Fundus photo; 2352 by 1568 pixels; 45° field of view:
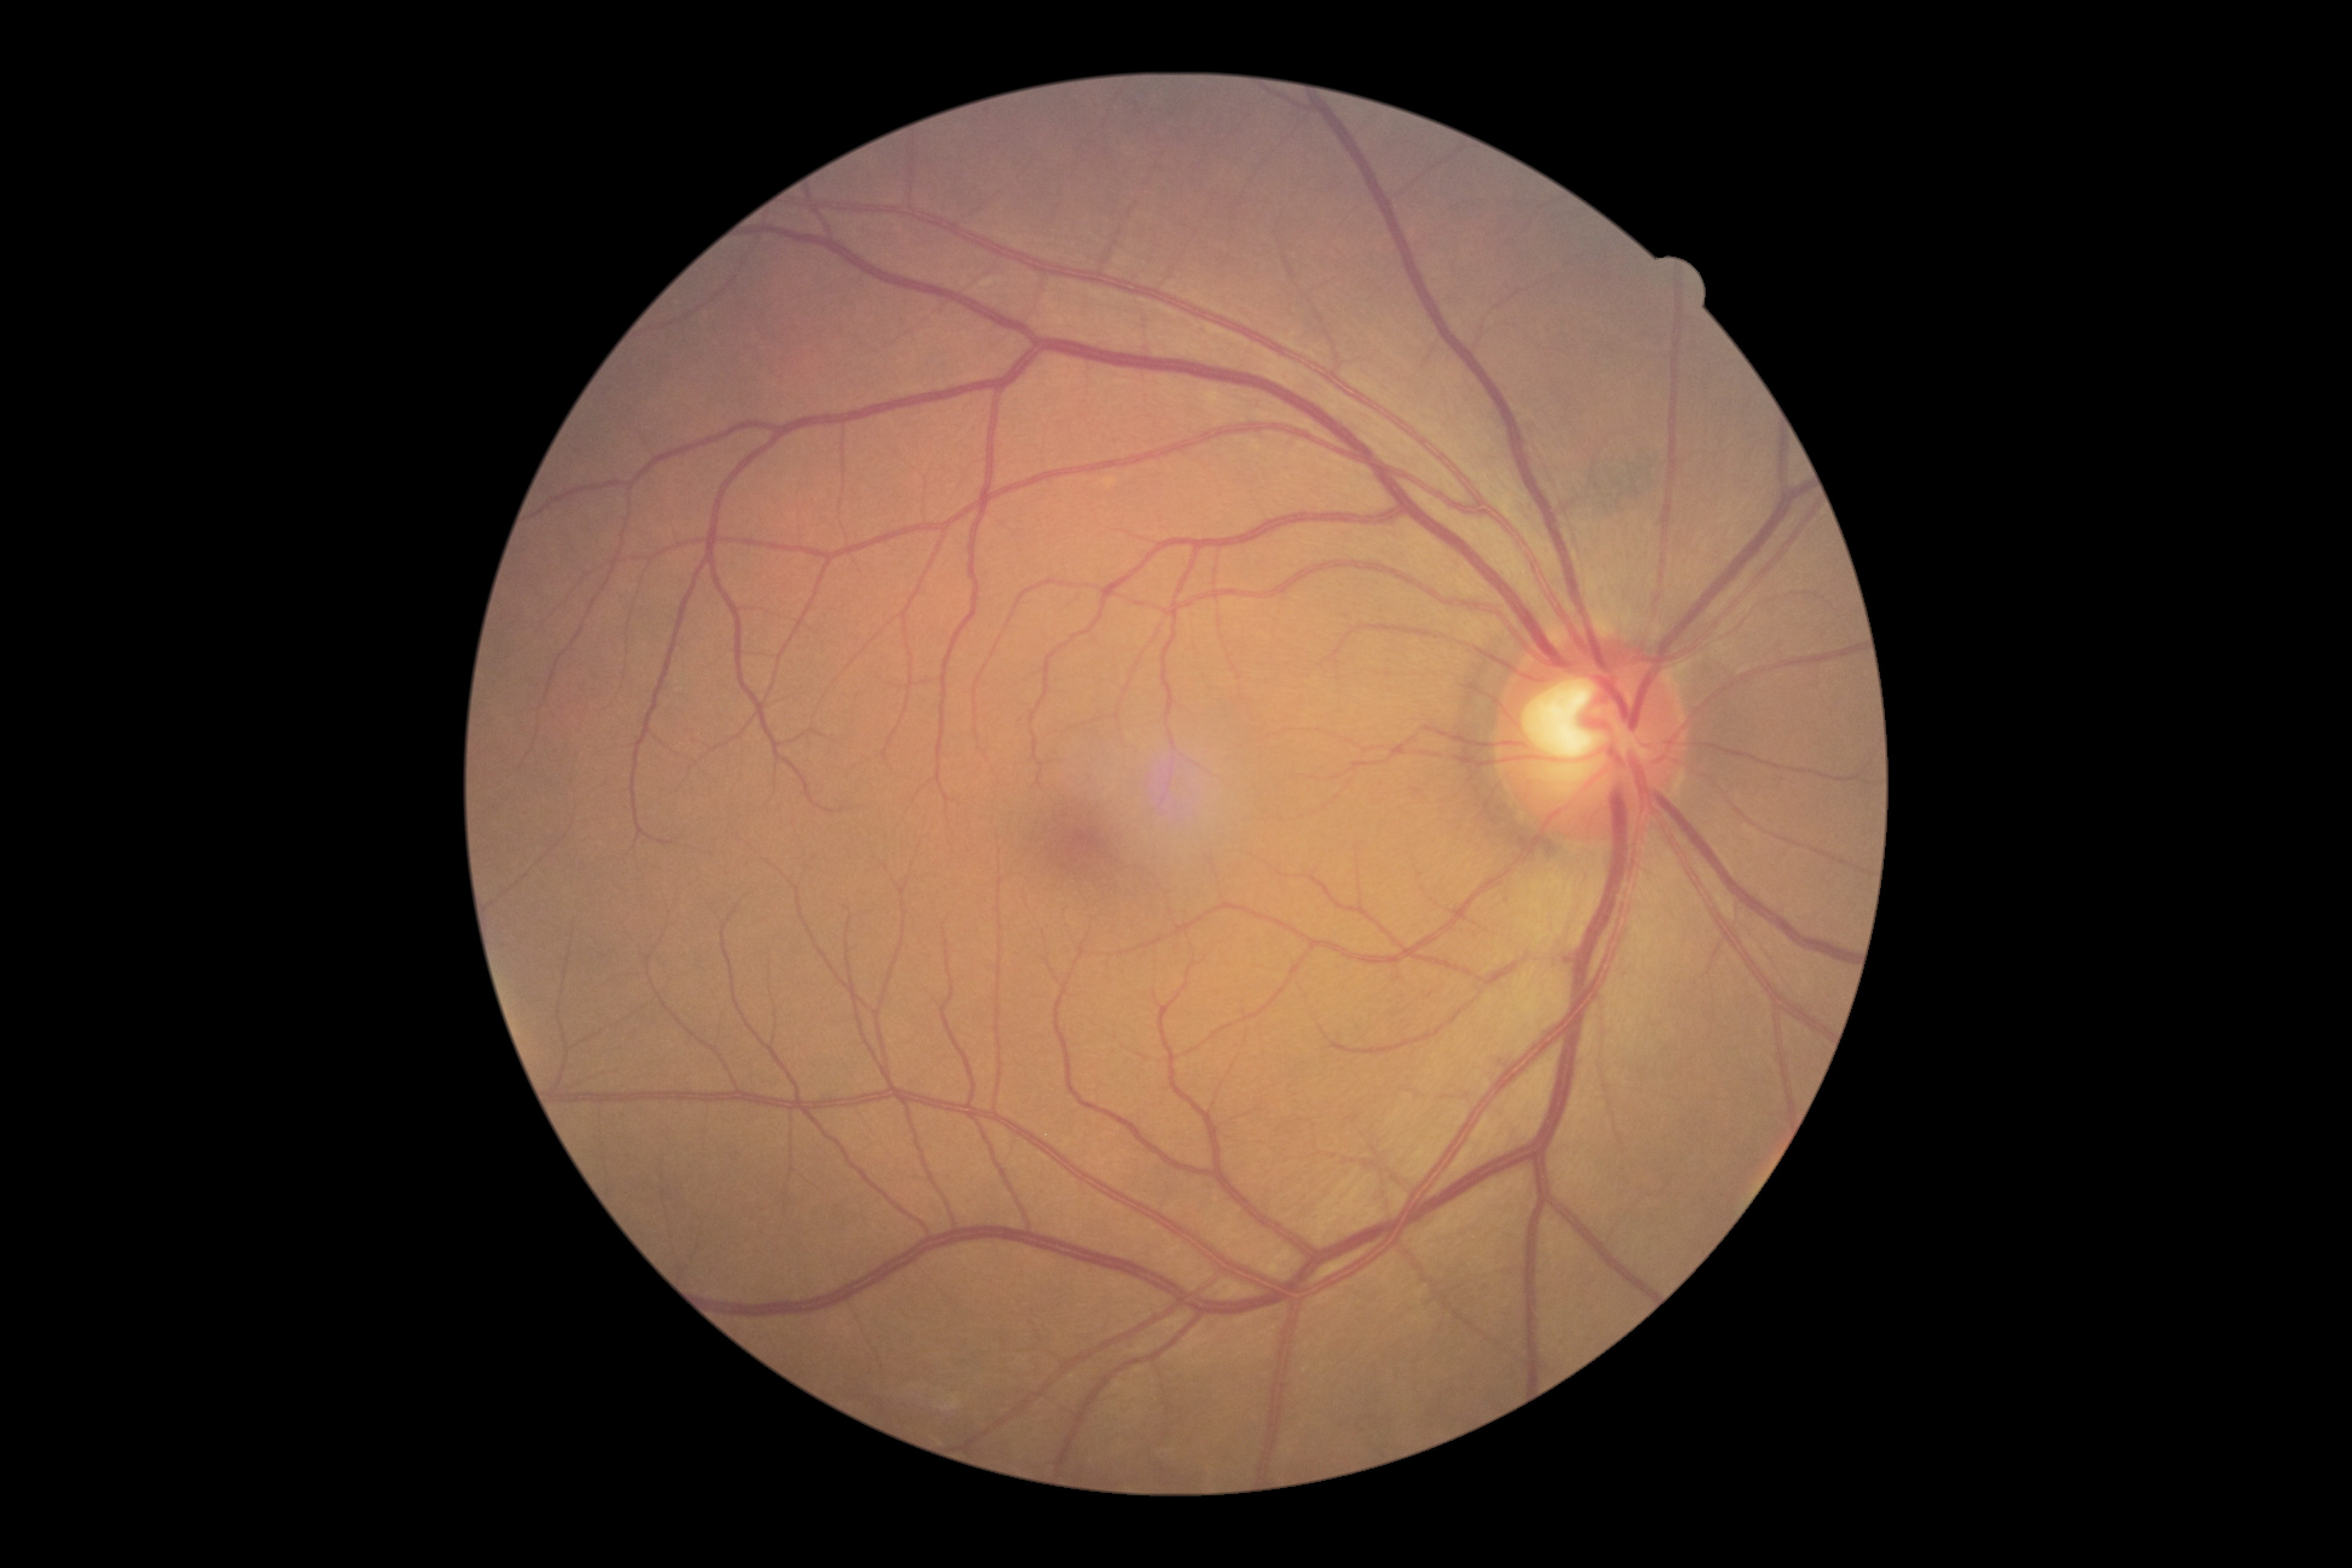 Retinopathy grade: 0/4.